Infant wide-field retinal image · acquired on the Clarity RetCam 3
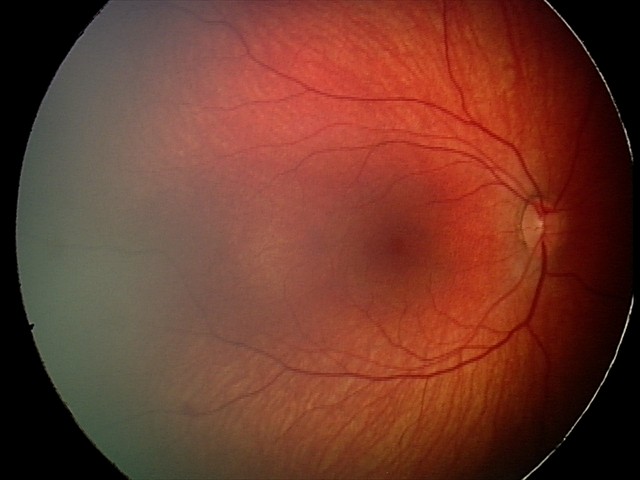

Screening series with retinal hemorrhages.